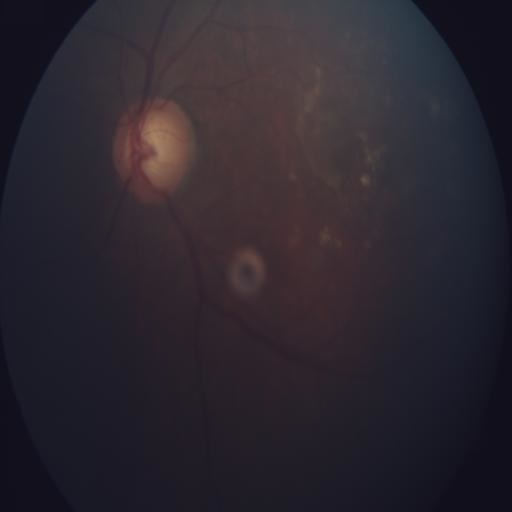
Findings:
- optic disc cupping (ODC)